45-degree field of view: 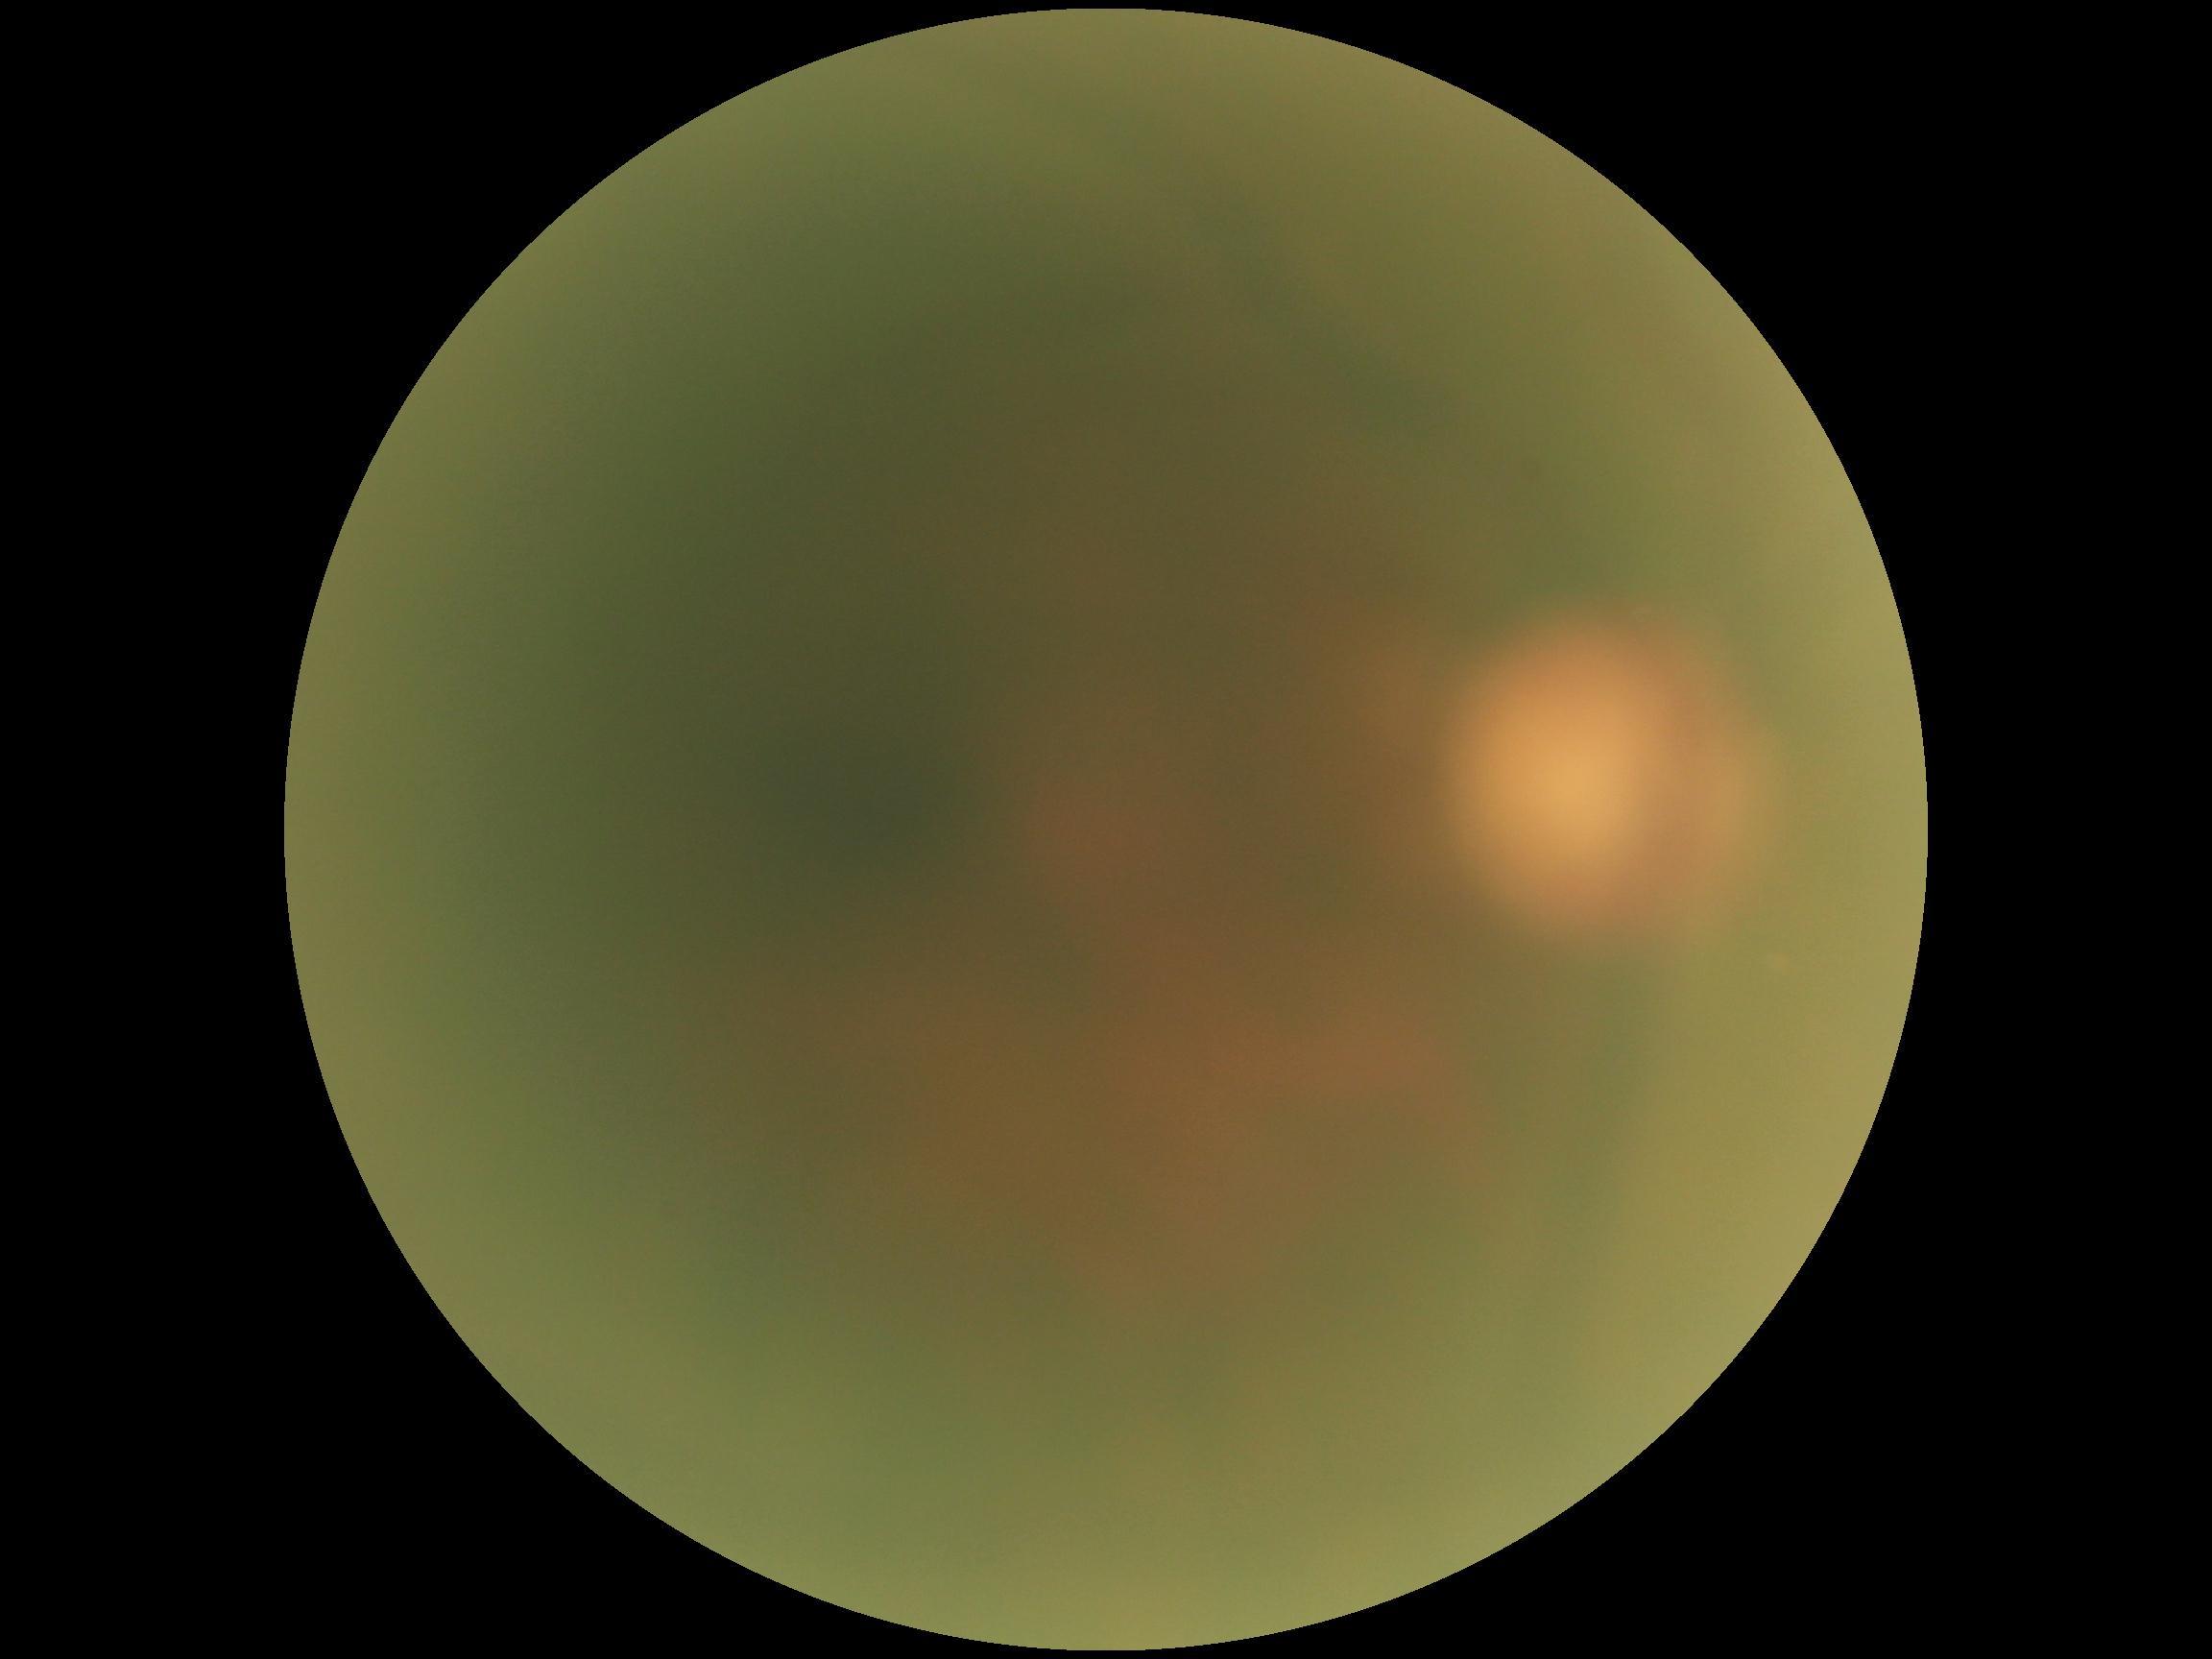
diabetic retinopathy (DR)=ungradable; image quality=insufficient.